RetCam wide-field infant fundus image. 640x480px — 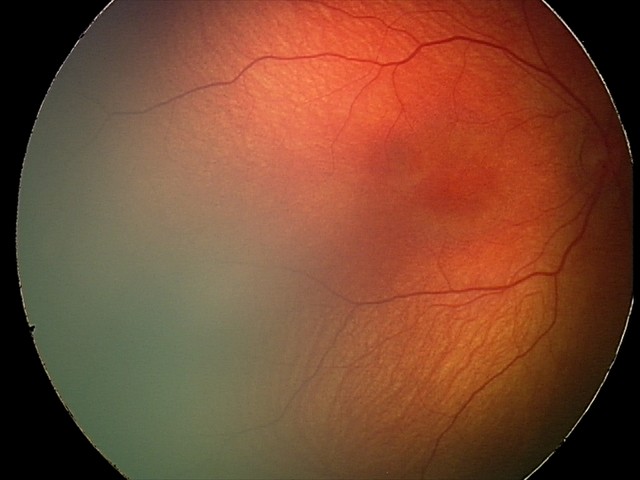
Normal screening examination.